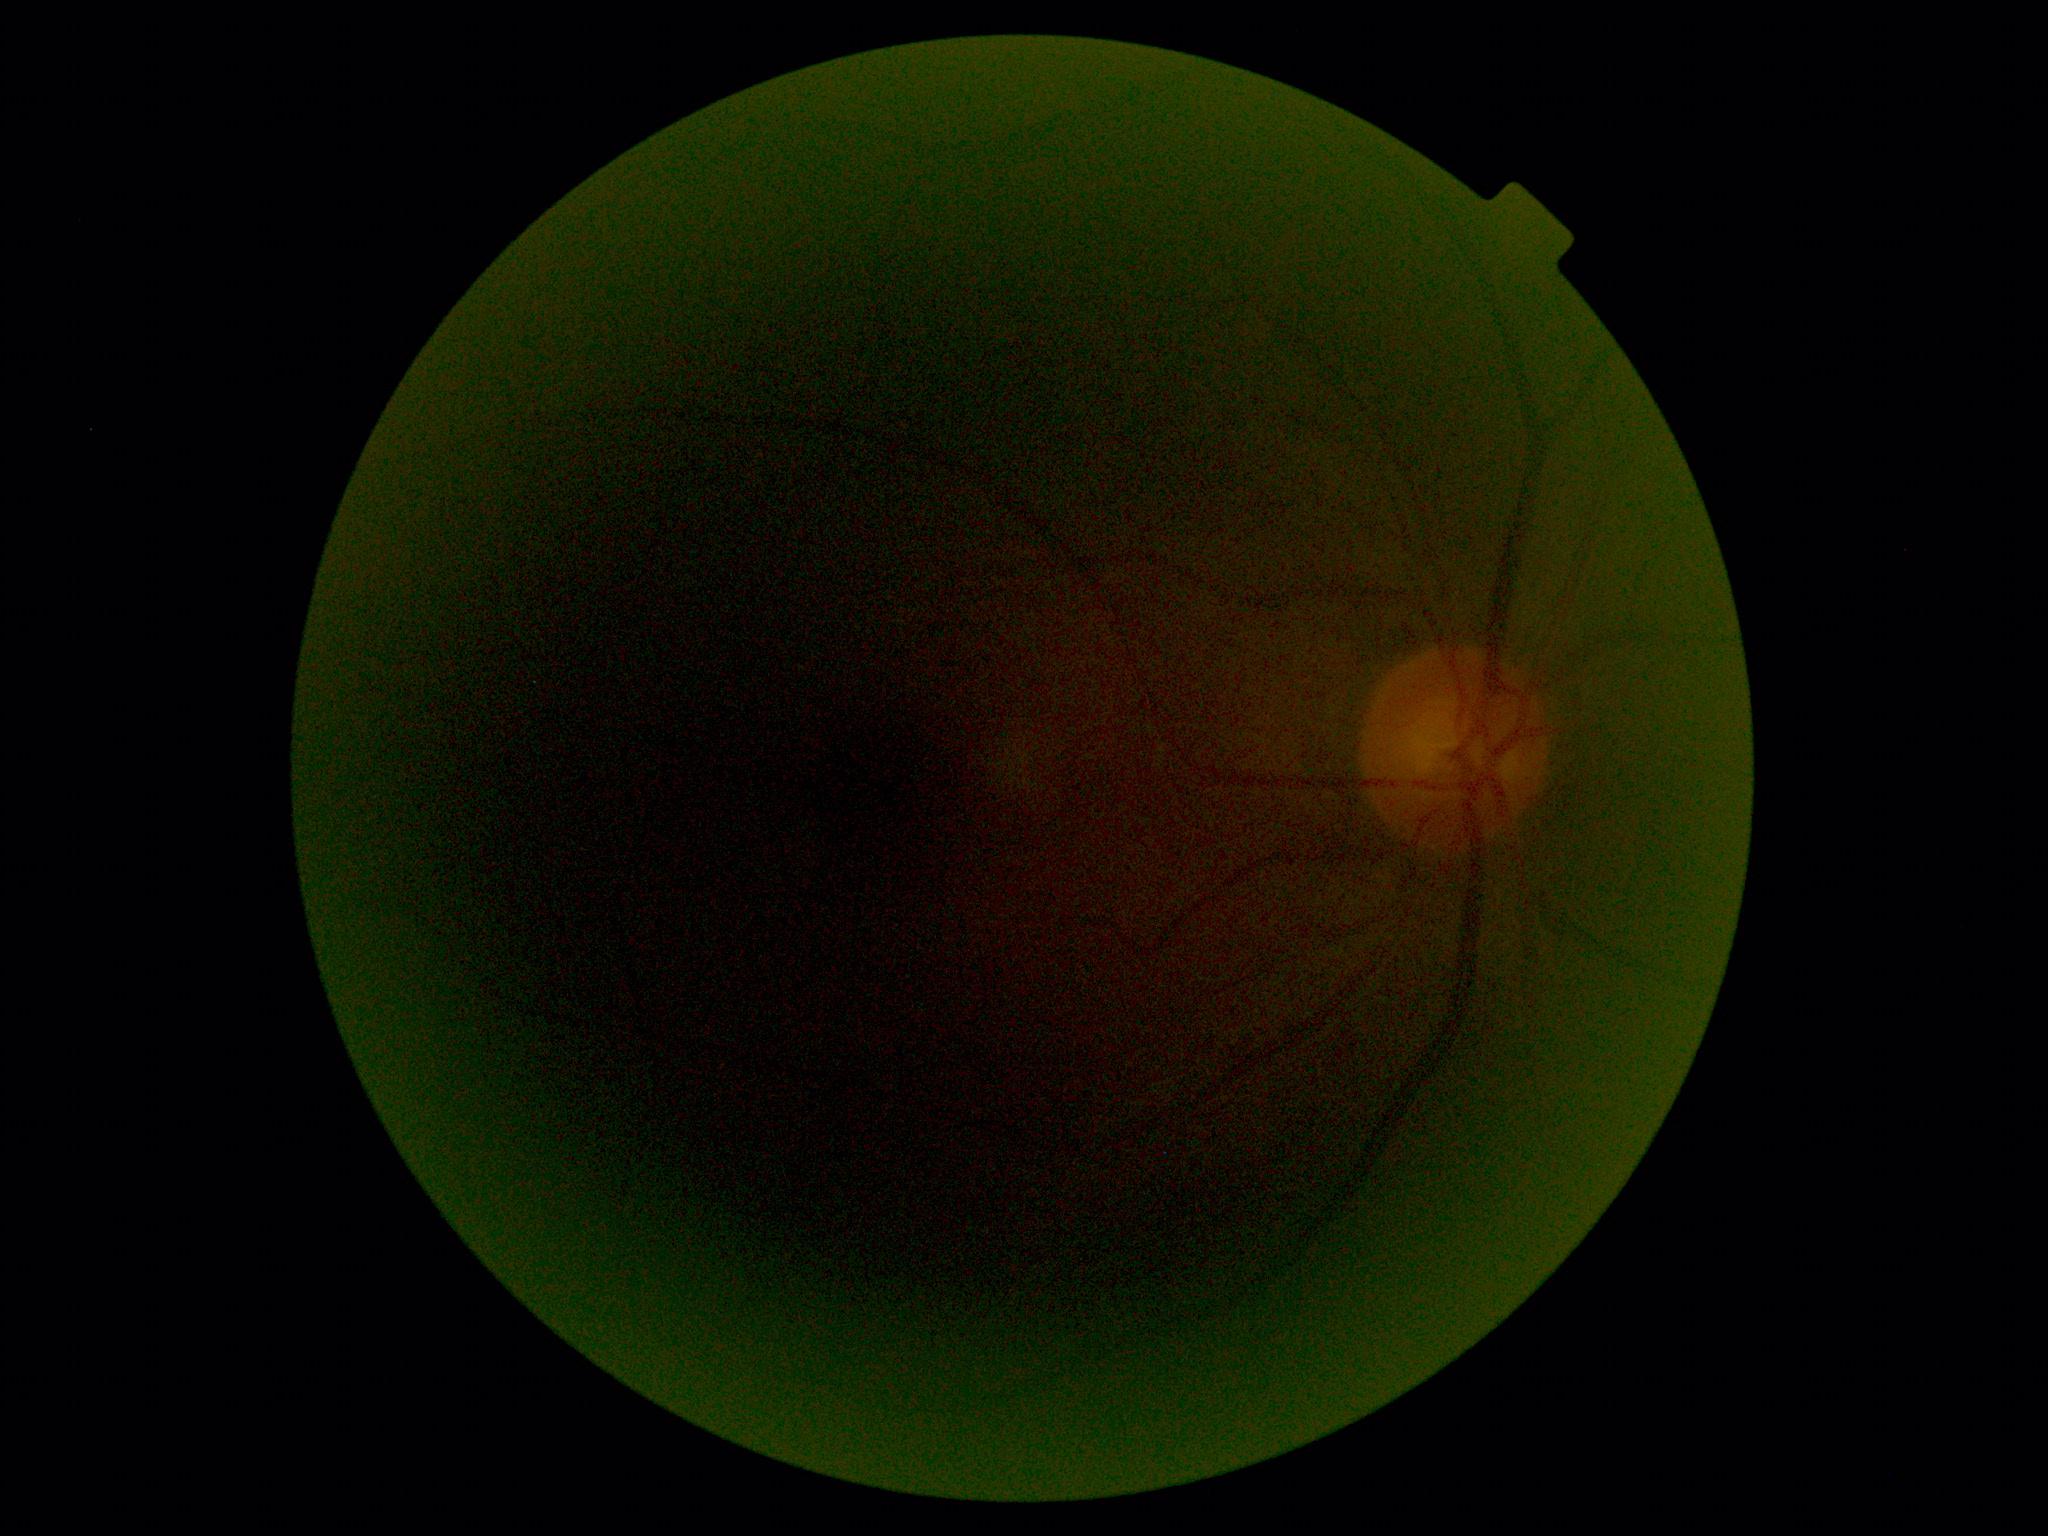
DR stage: ungradable. Image quality is insufficient for diabetic retinopathy assessment.